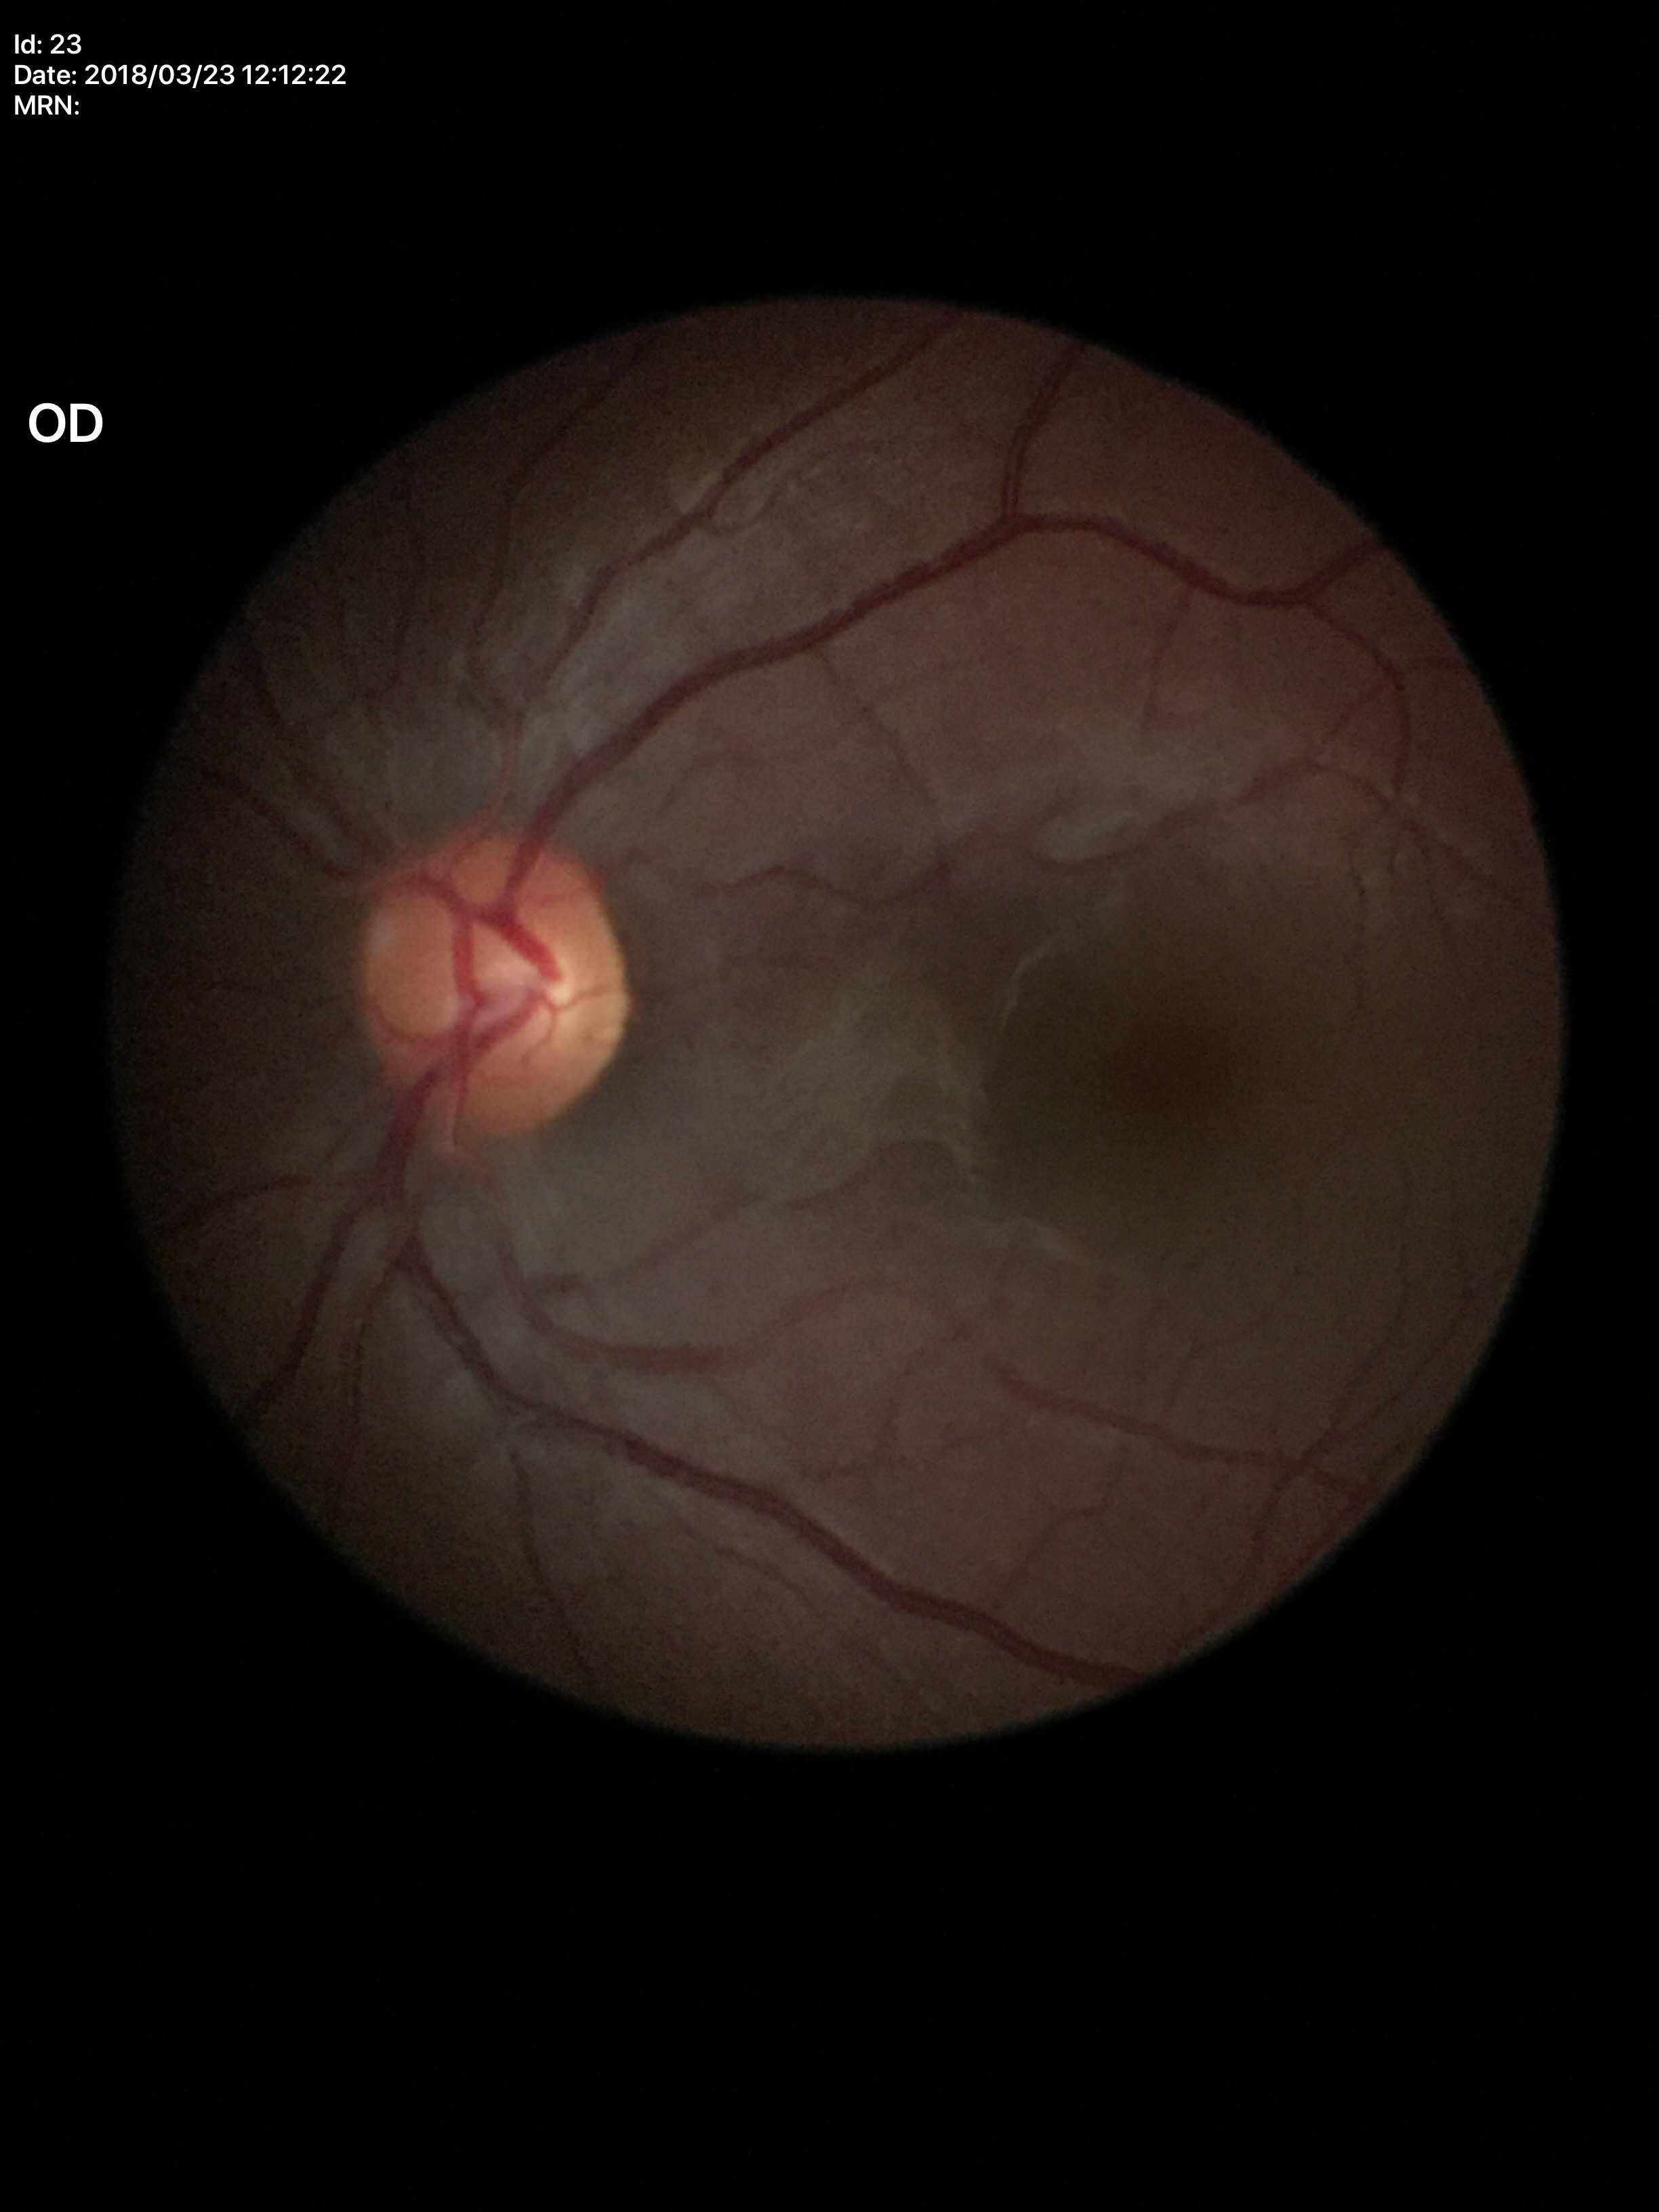 Q: What is the glaucoma assessment?
A: no suspicious findings
Q: What is the VCDR?
A: 0.48